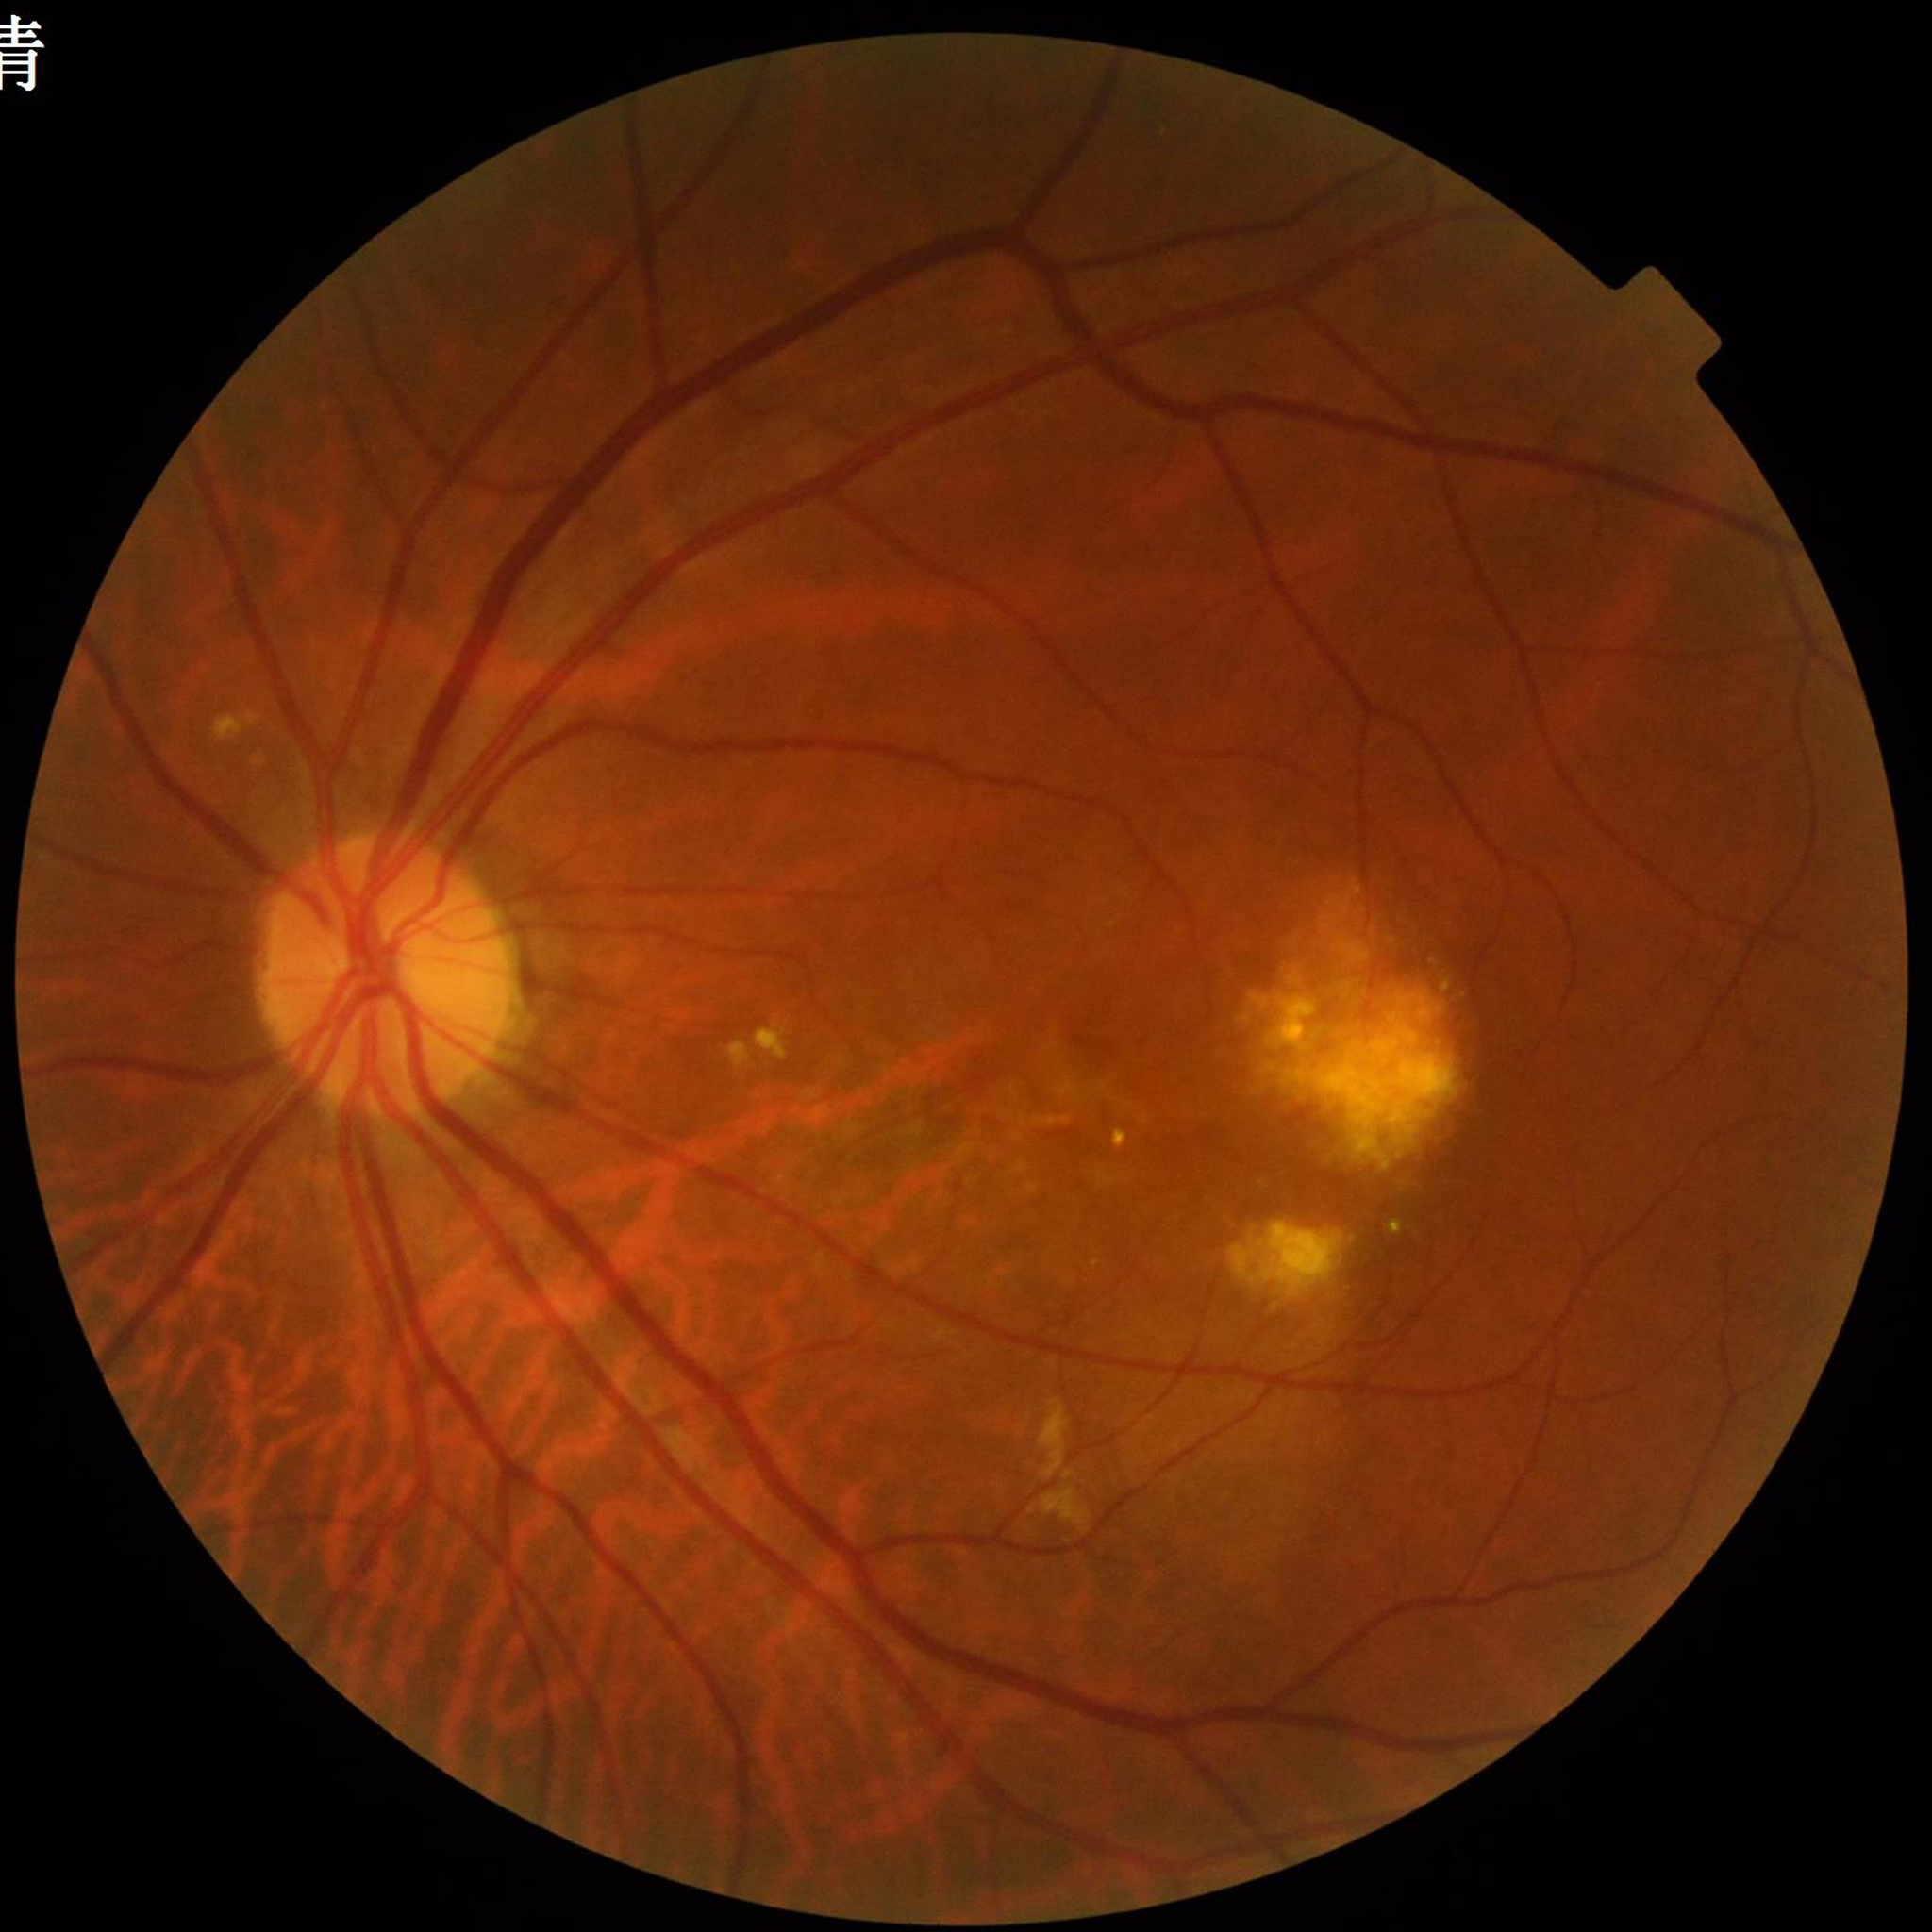
Diagnosed with age-related macular degeneration (AMD). Quality: adequate.